Infant wide-field retinal image · captured with the Phoenix ICON (100° field of view)
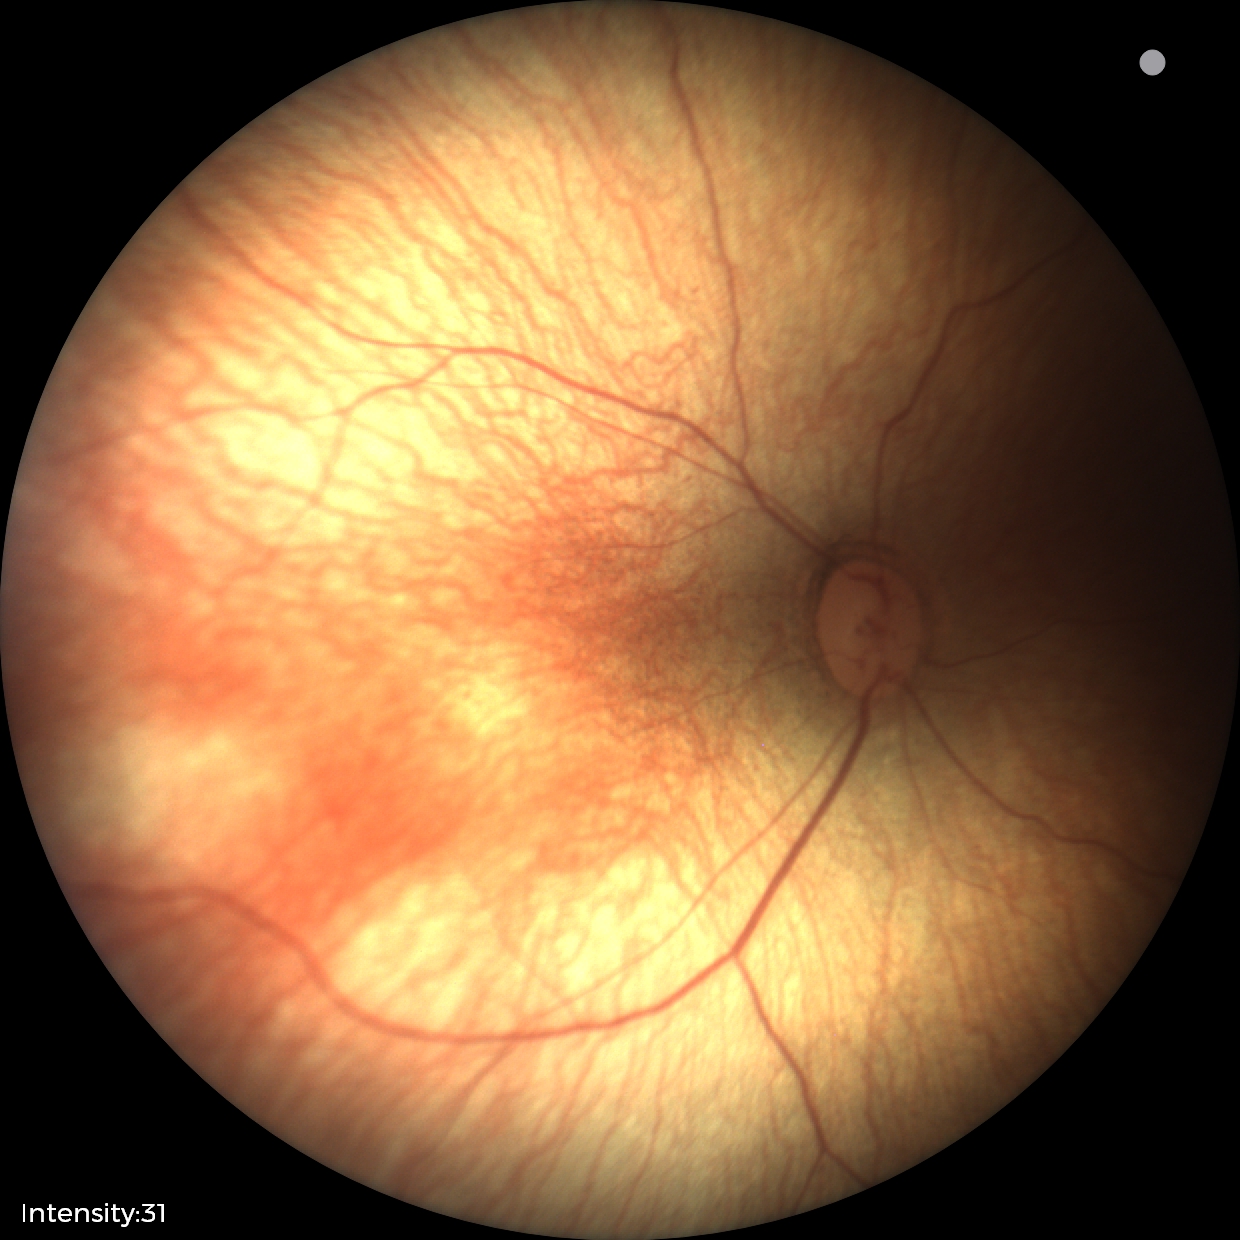
Diagnosis: no pathology identified